Diabetic retinopathy graded by the modified Davis classification
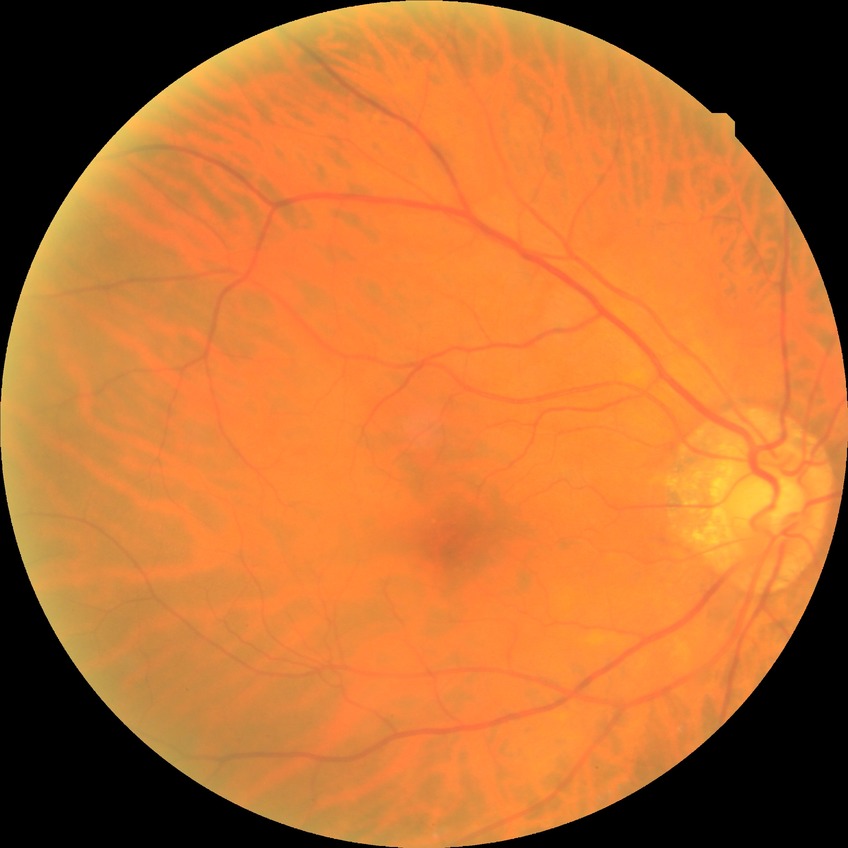

DR grade is NDR.